DR severity per modified Davis staging · posterior pole photograph · 45-degree field of view
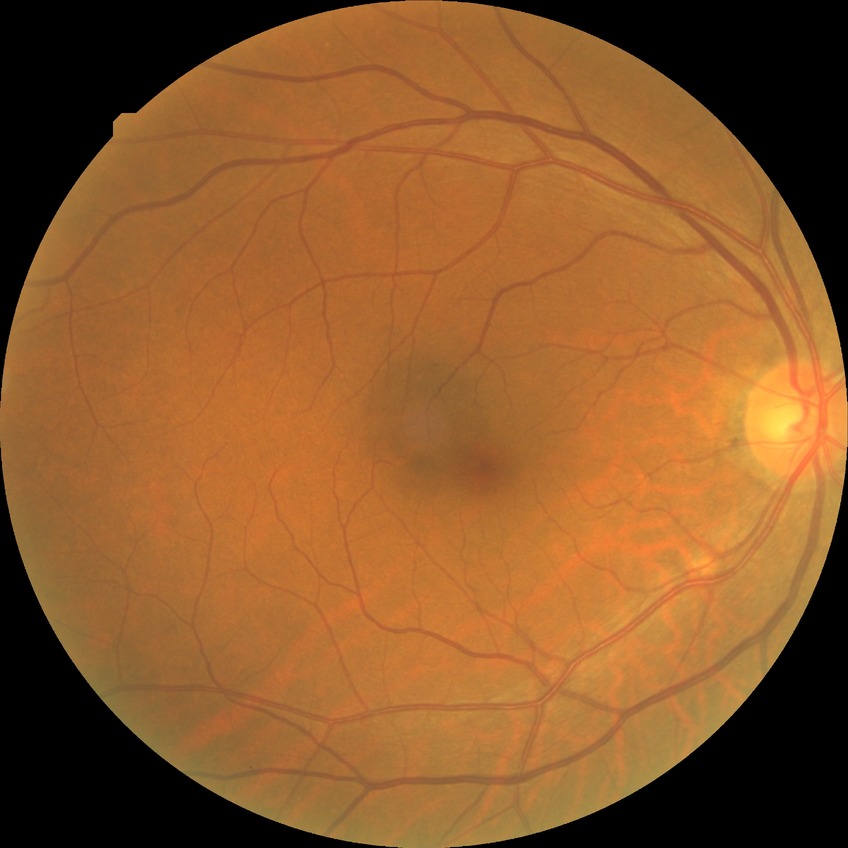
DR class: non-proliferative diabetic retinopathy. Diabetic retinopathy (DR): simple diabetic retinopathy (SDR).